Camera: Kowa VX-10α. Captured after pupil dilation. Centered on the macula. CFP:
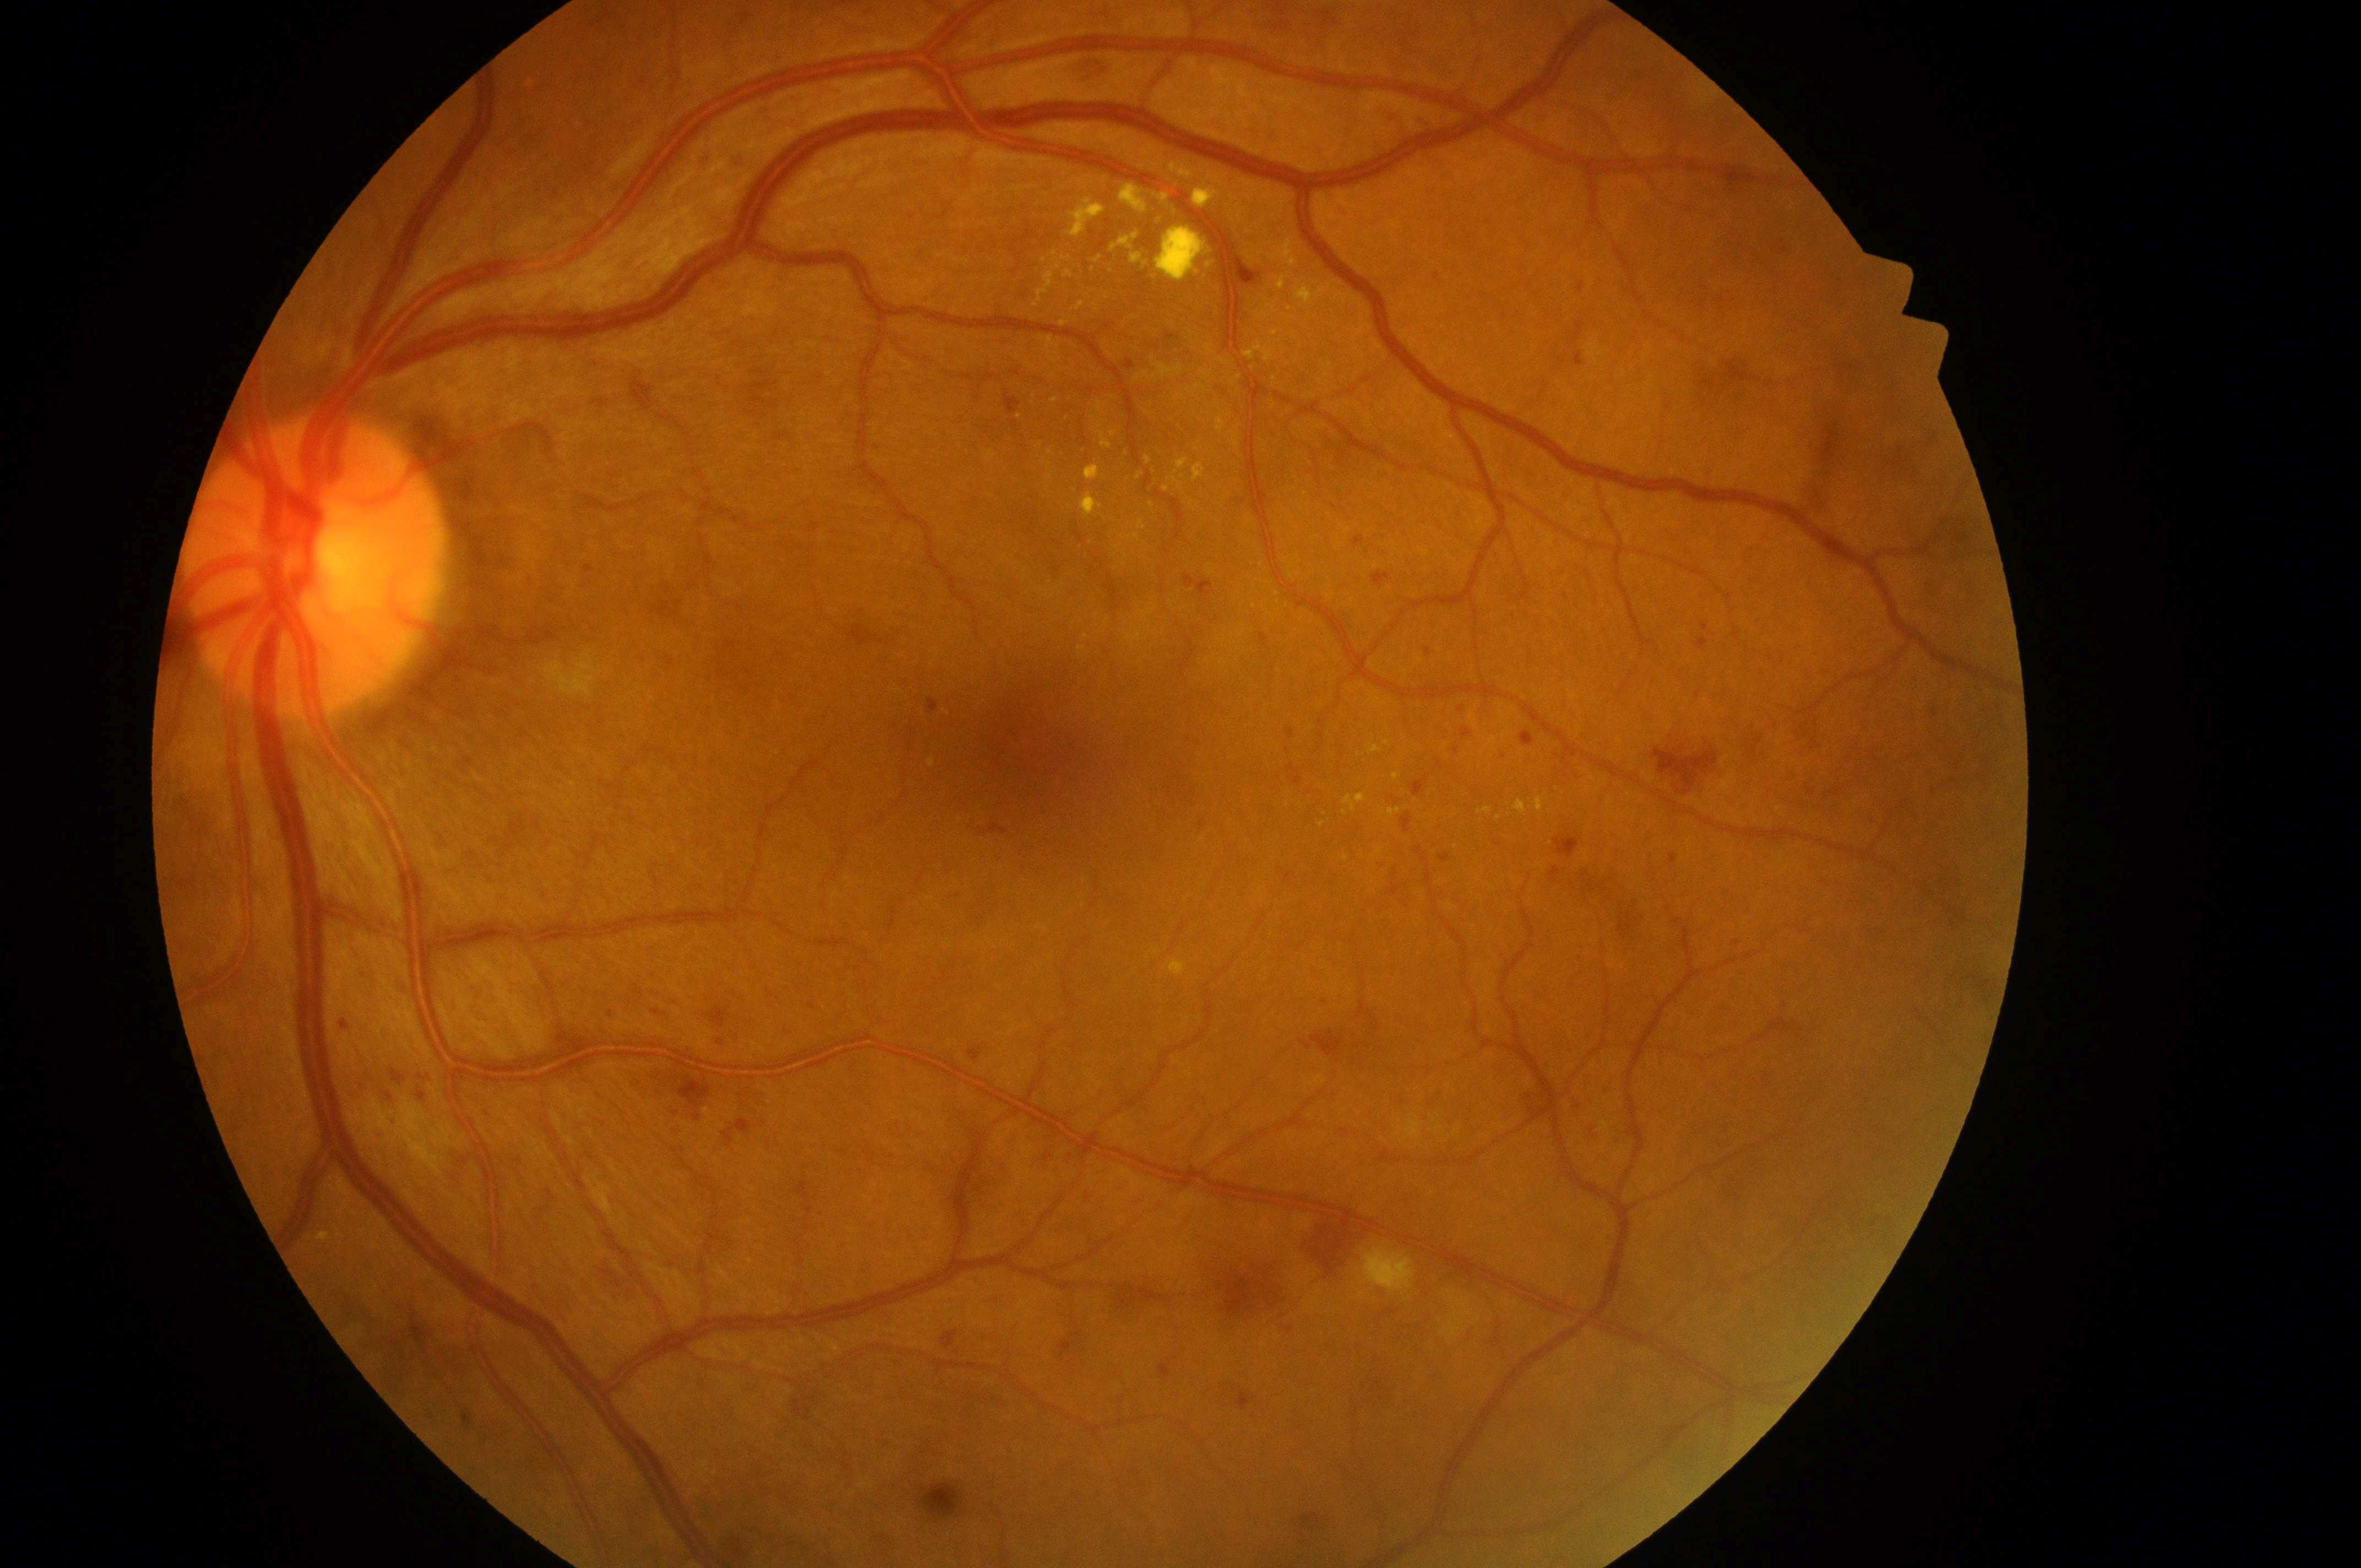
{
  "dme_grade": "high risk (grade 2)",
  "fovea": "(x=1031, y=759)",
  "dr_grade": "severe NPDR (grade 3)",
  "optic_disc": "(x=307, y=573)",
  "eye": "oculus sinister",
  "dr_category": "non-proliferative diabetic retinopathy"
}